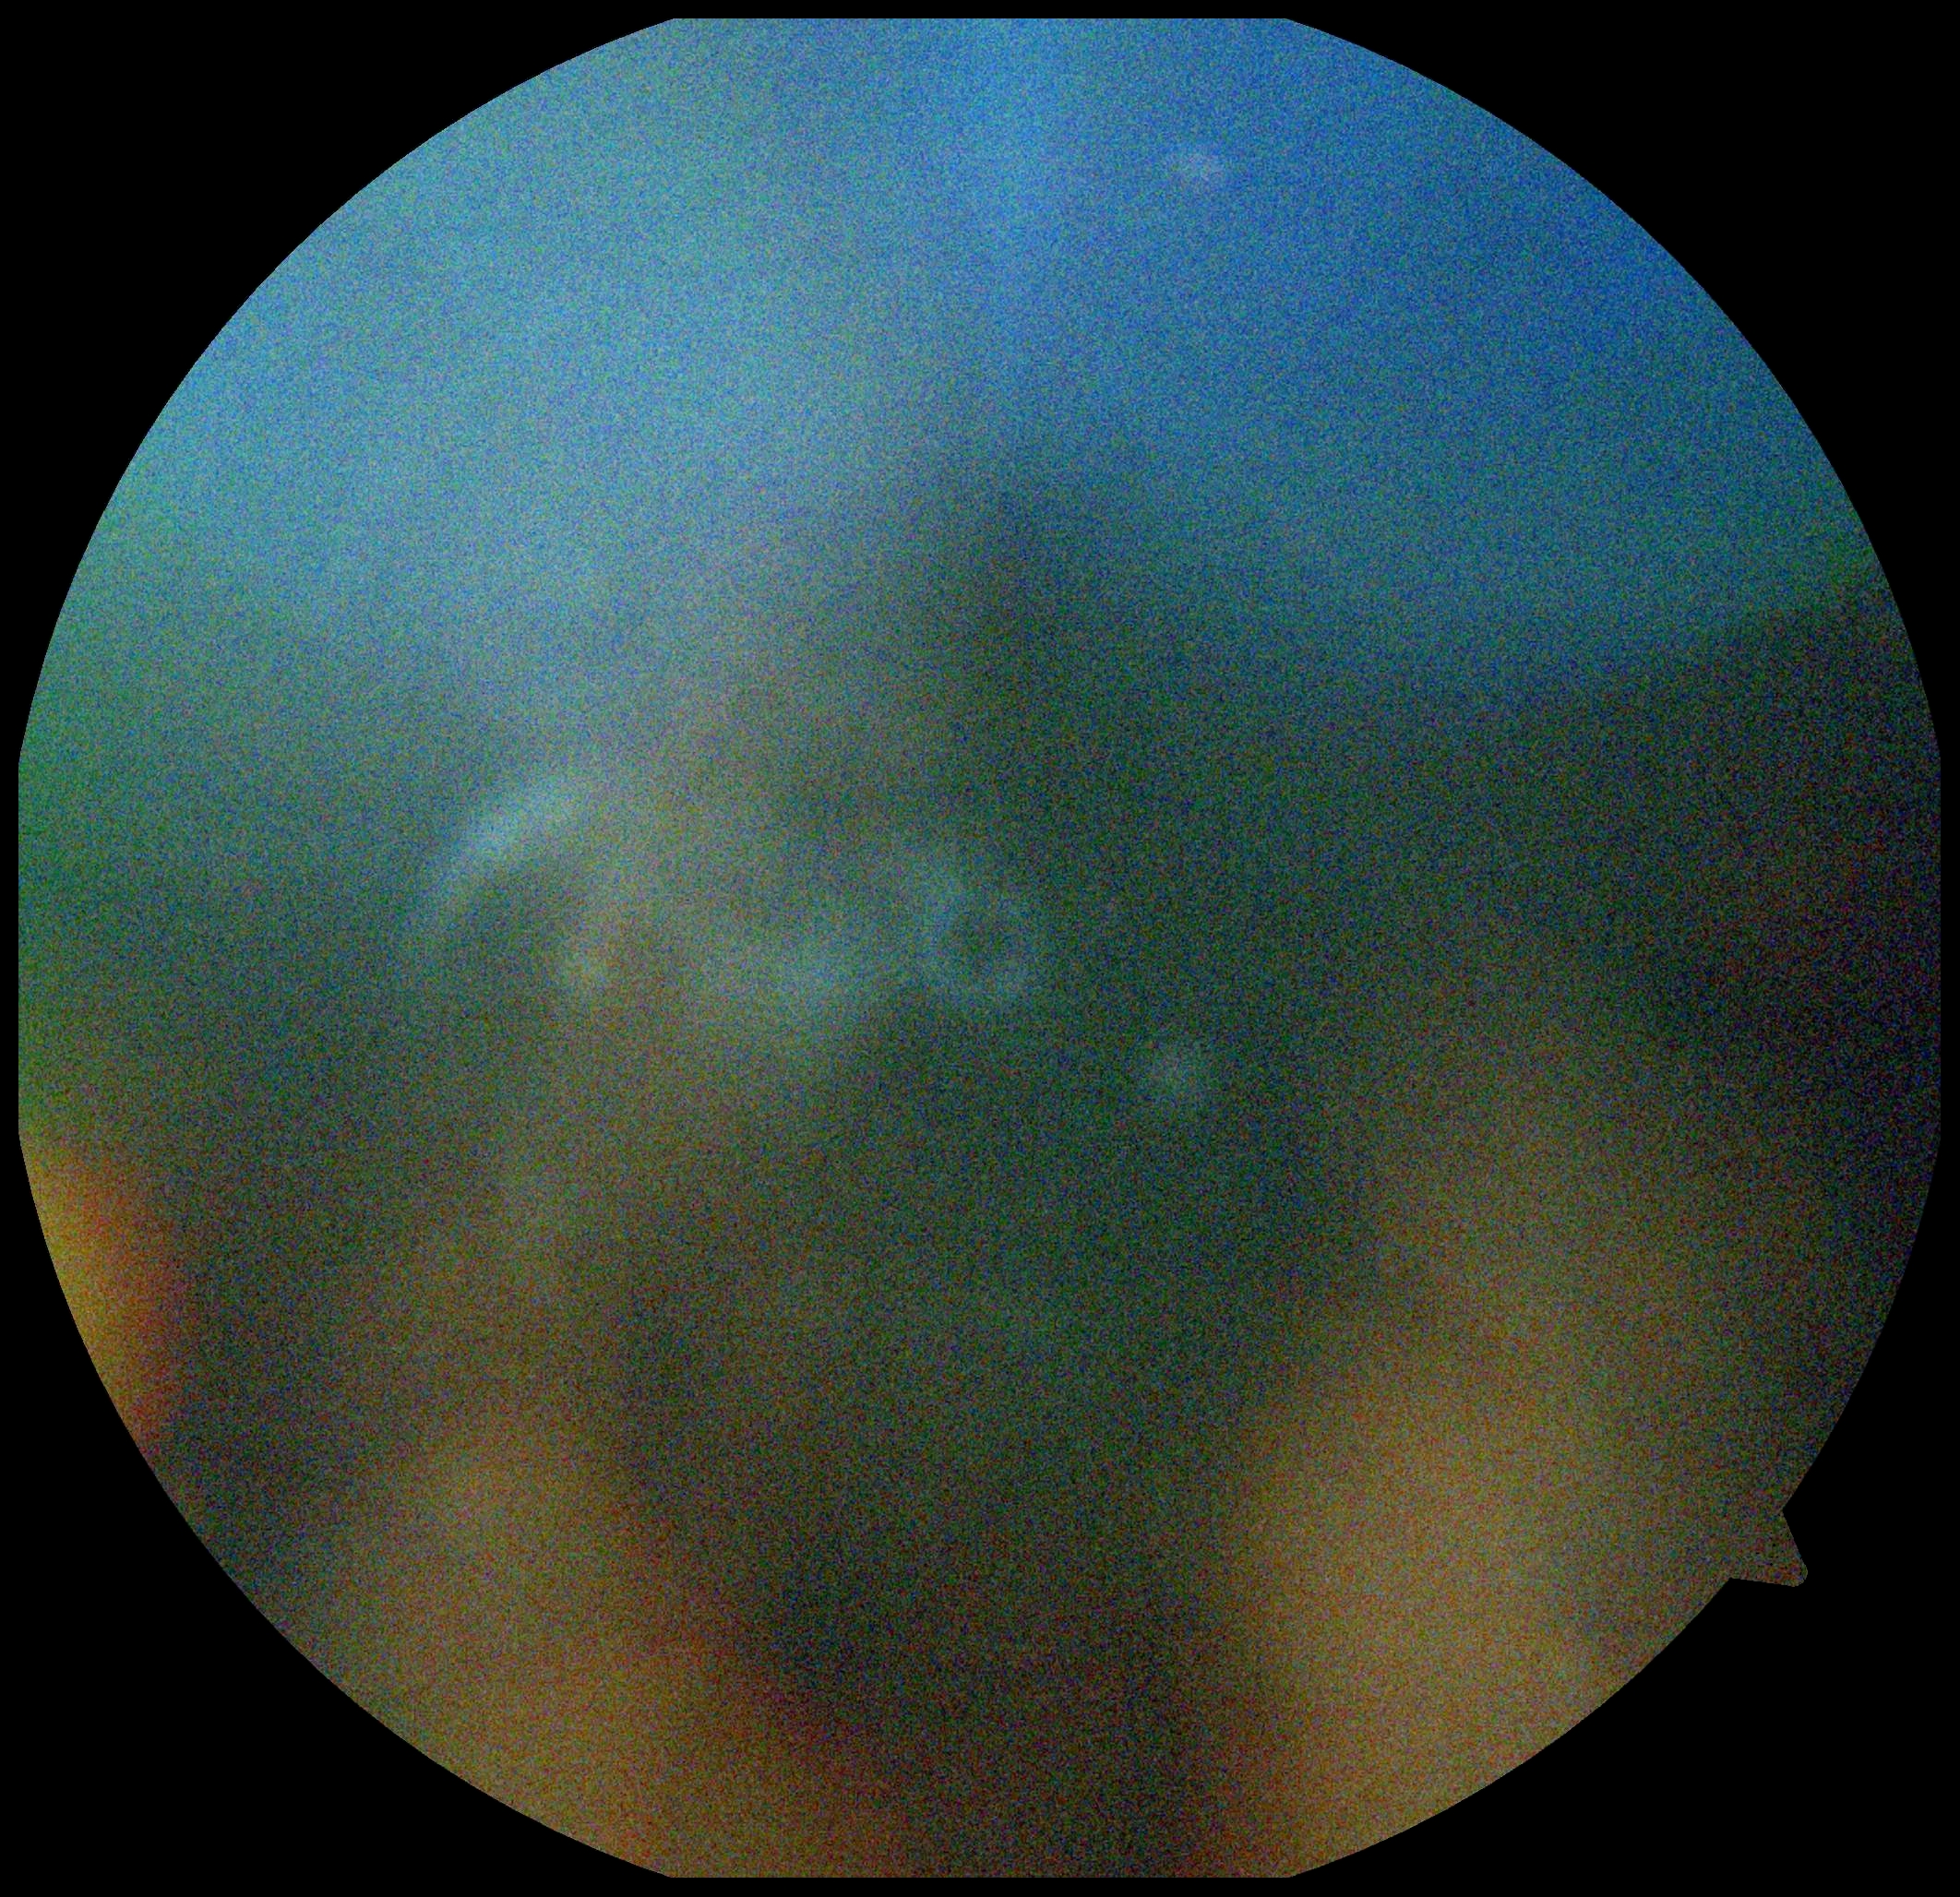

Diabetic retinopathy (DR) is ungradable.